Image size 2352x1568, retinal fundus photograph: 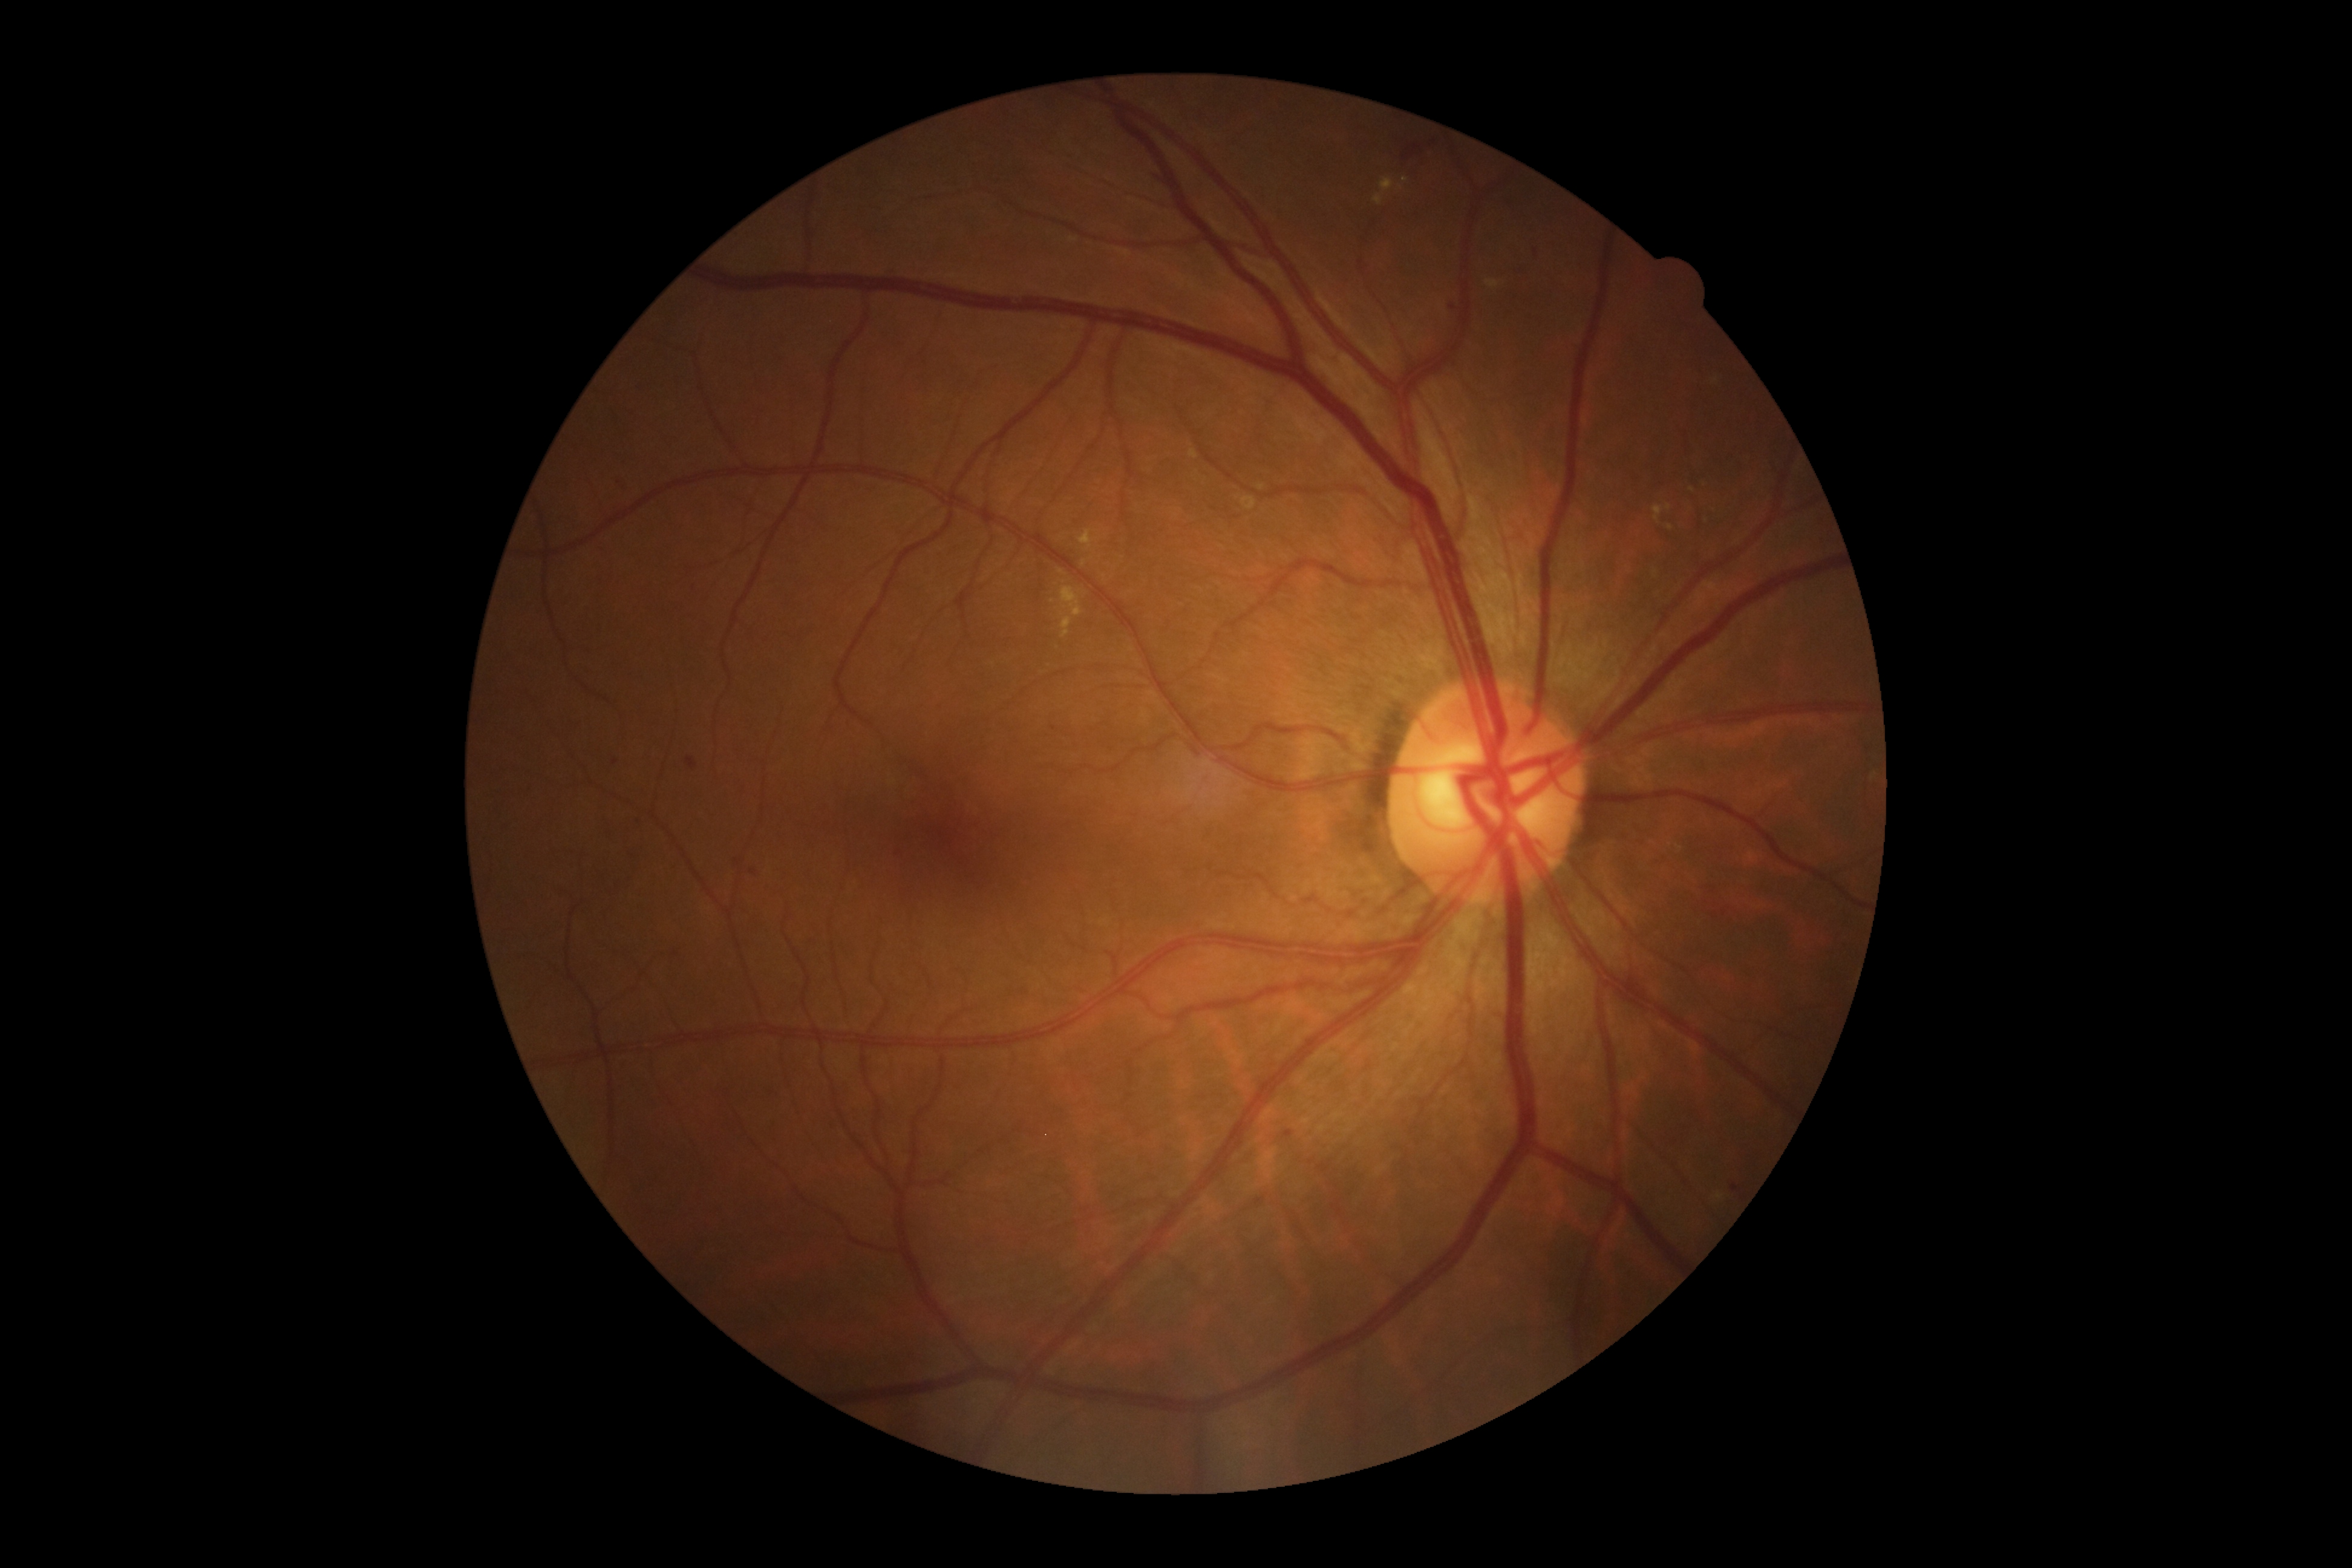
Diabetic retinopathy (DR): moderate non-proliferative diabetic retinopathy (grade 2)
Lesions identified (partial list):
• hard exudates (EXs) (partial): 1060 586 1083 616; 1241 498 1256 511; 1079 529 1098 551; 1062 616 1073 639; 1653 504 1671 523; 1486 280 1500 290; 1374 177 1394 206
• EXs (small, approximate centers) near 1084, 563; 1671, 528; 1692, 489; 1405, 180; 1261, 488; 1062, 614; 1717, 380; 1062, 572; 1400, 188
• microaneurysms (MAs) (partial): 622 483 630 493; 1254 1197 1266 1208; 687 757 697 770; 1731 1184 1739 1192; 1535 249 1538 257; 1450 304 1459 312; 1283 1132 1294 1138; 735 858 743 866
• MAs (small, approximate centers) near 754, 874; 899, 854; 616, 762
• hemorrhages (HEs): 1154 177 1173 187; 1403 145 1422 160
• soft exudates (SEs): none